Optic disc-centered crop from a color fundus photograph: 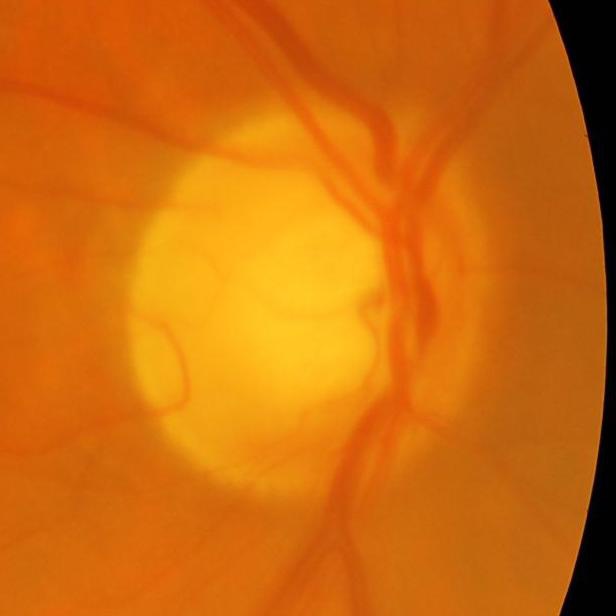

Glaucoma status: present.